No pharmacologic dilation
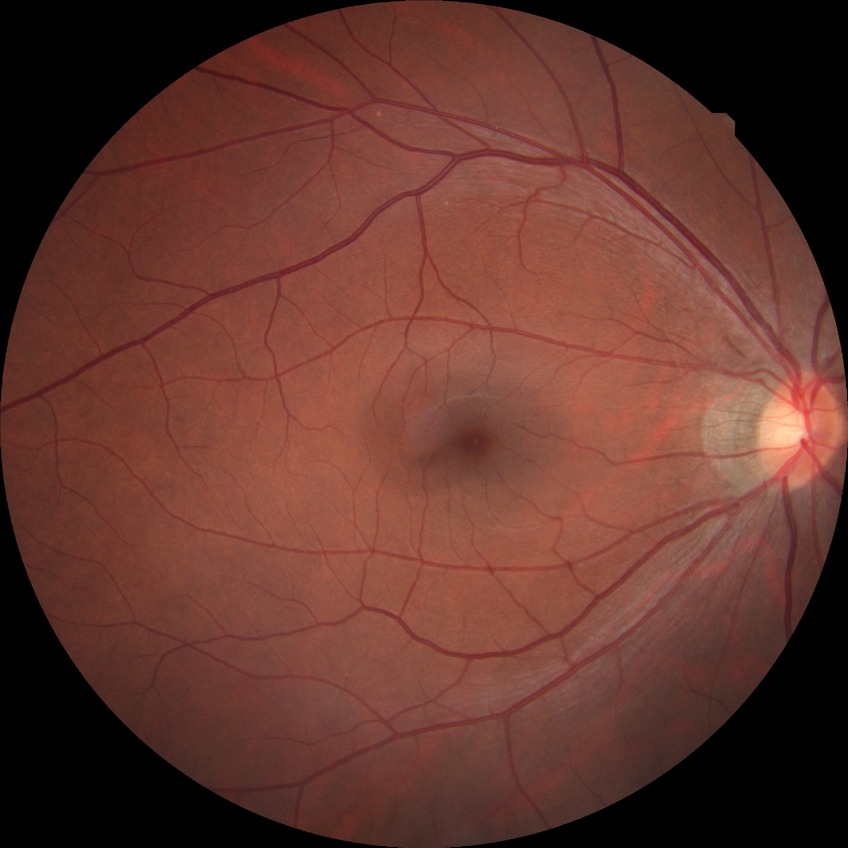
diabetic retinopathy (DR)@SDR (simple diabetic retinopathy).